Image size 2048x1536 — 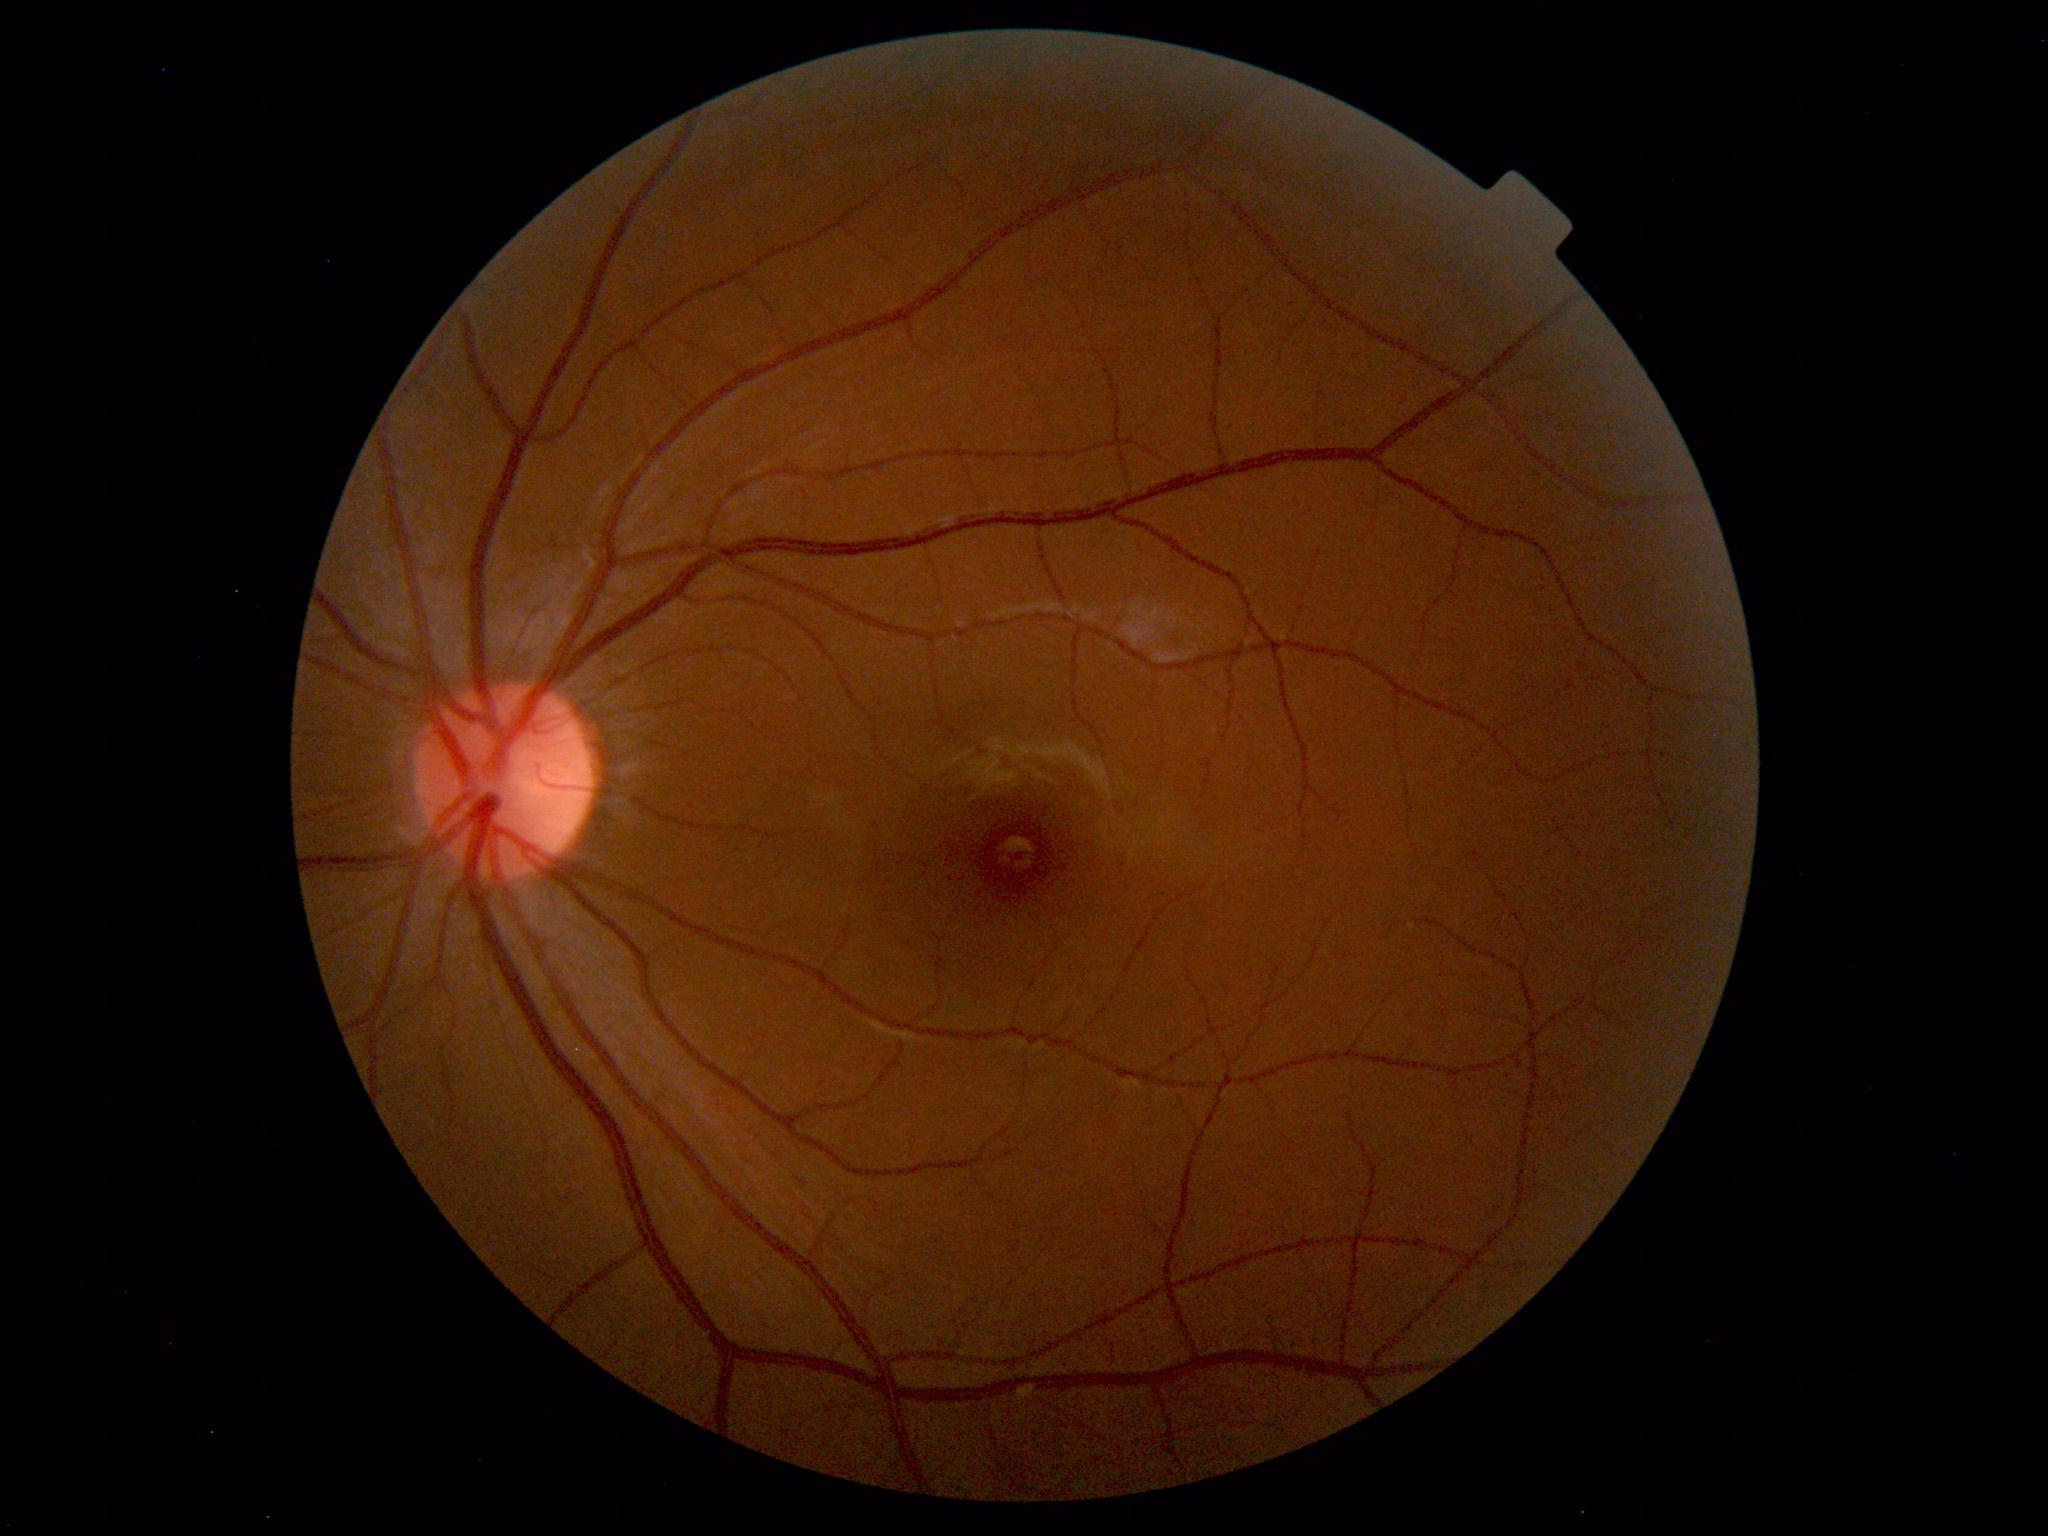

Unremarkable color fundus photograph.